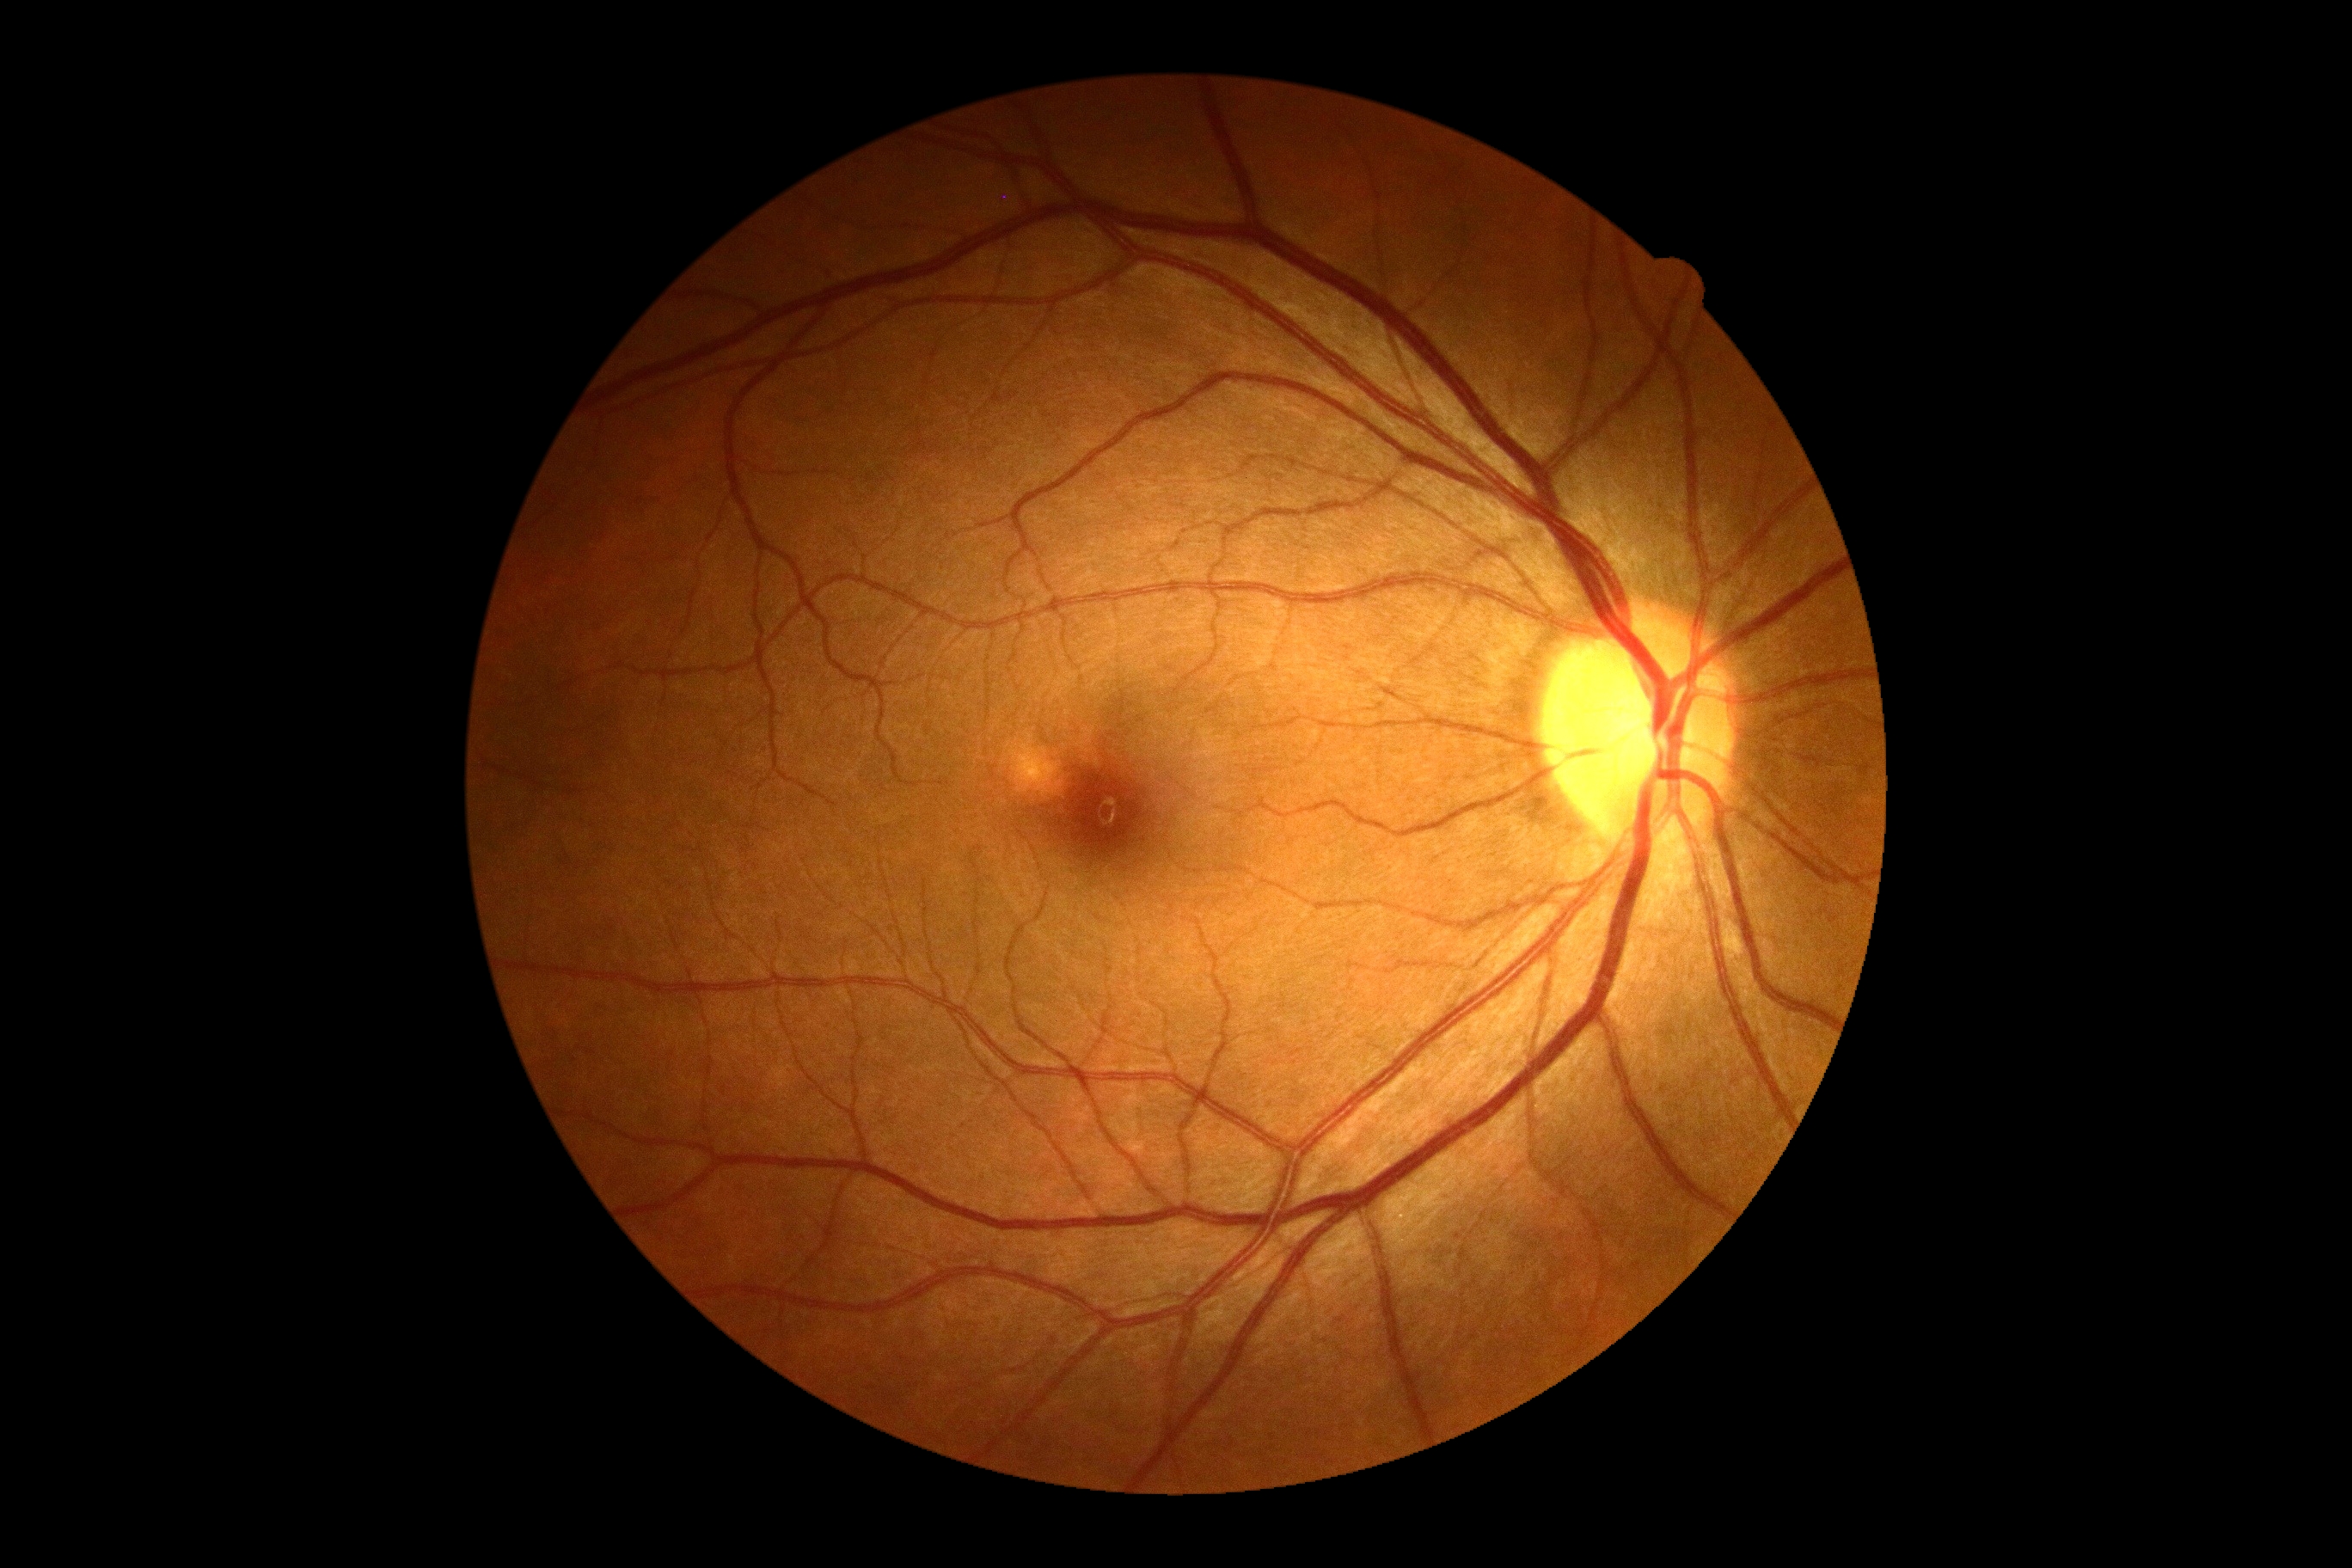

  dr_grade: no apparent retinopathy (grade 0)